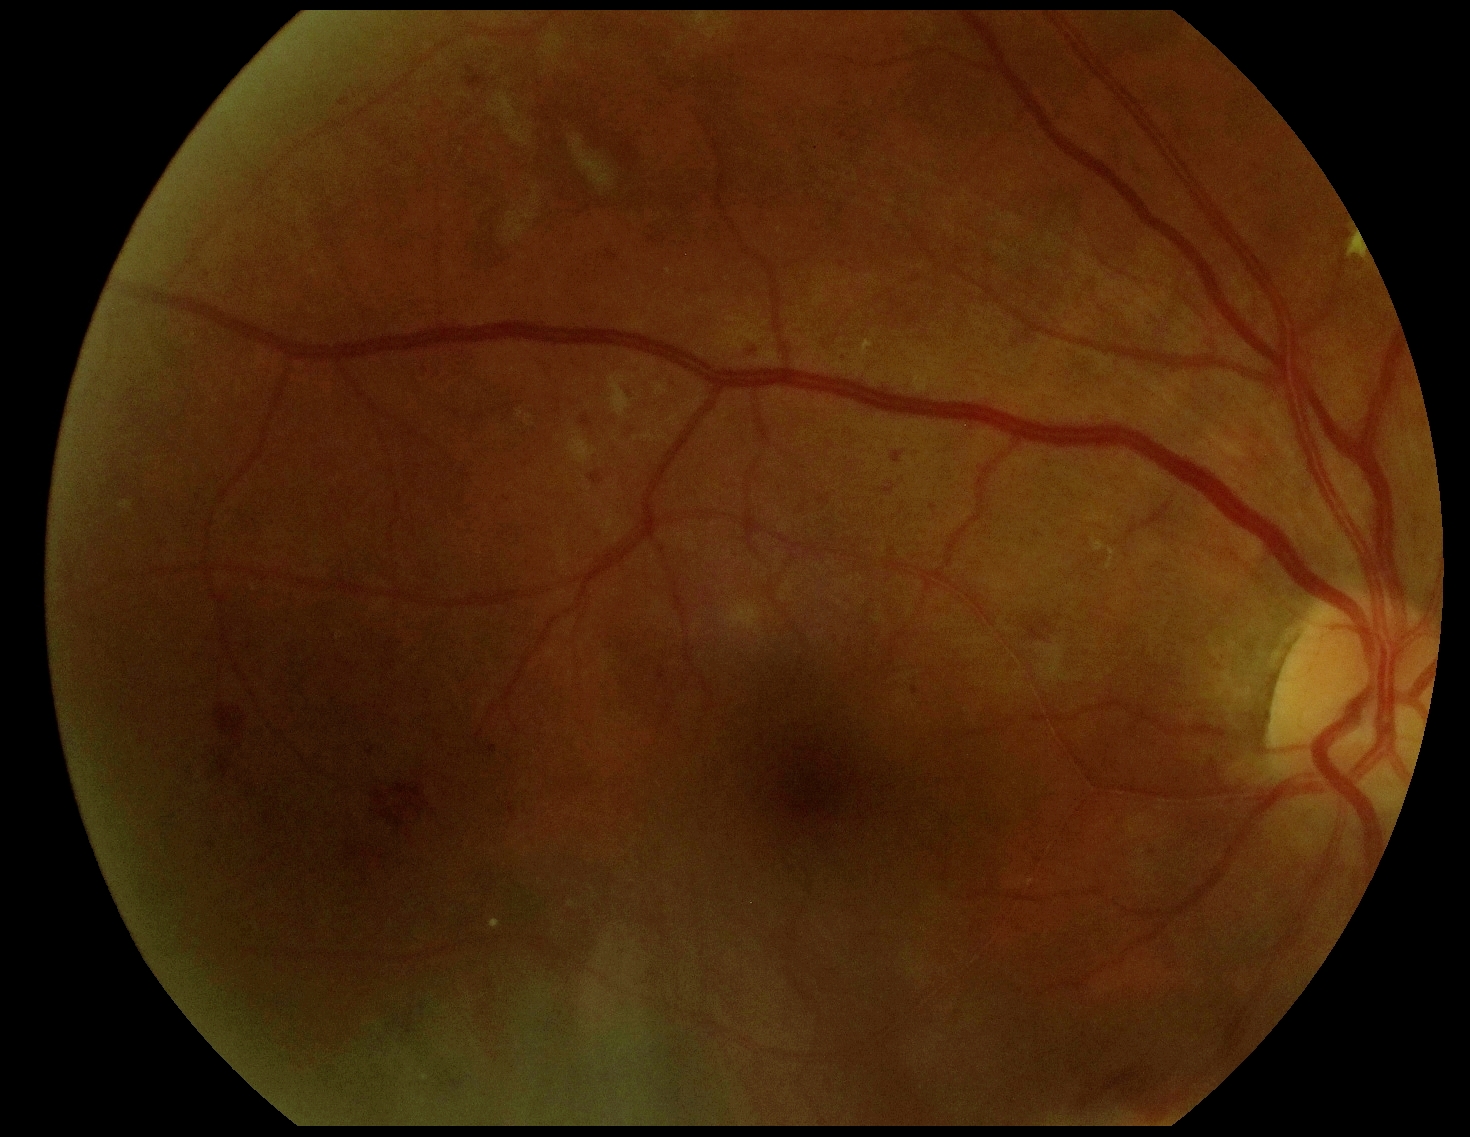 Diabetic retinopathy grade is 2 (moderate NPDR).